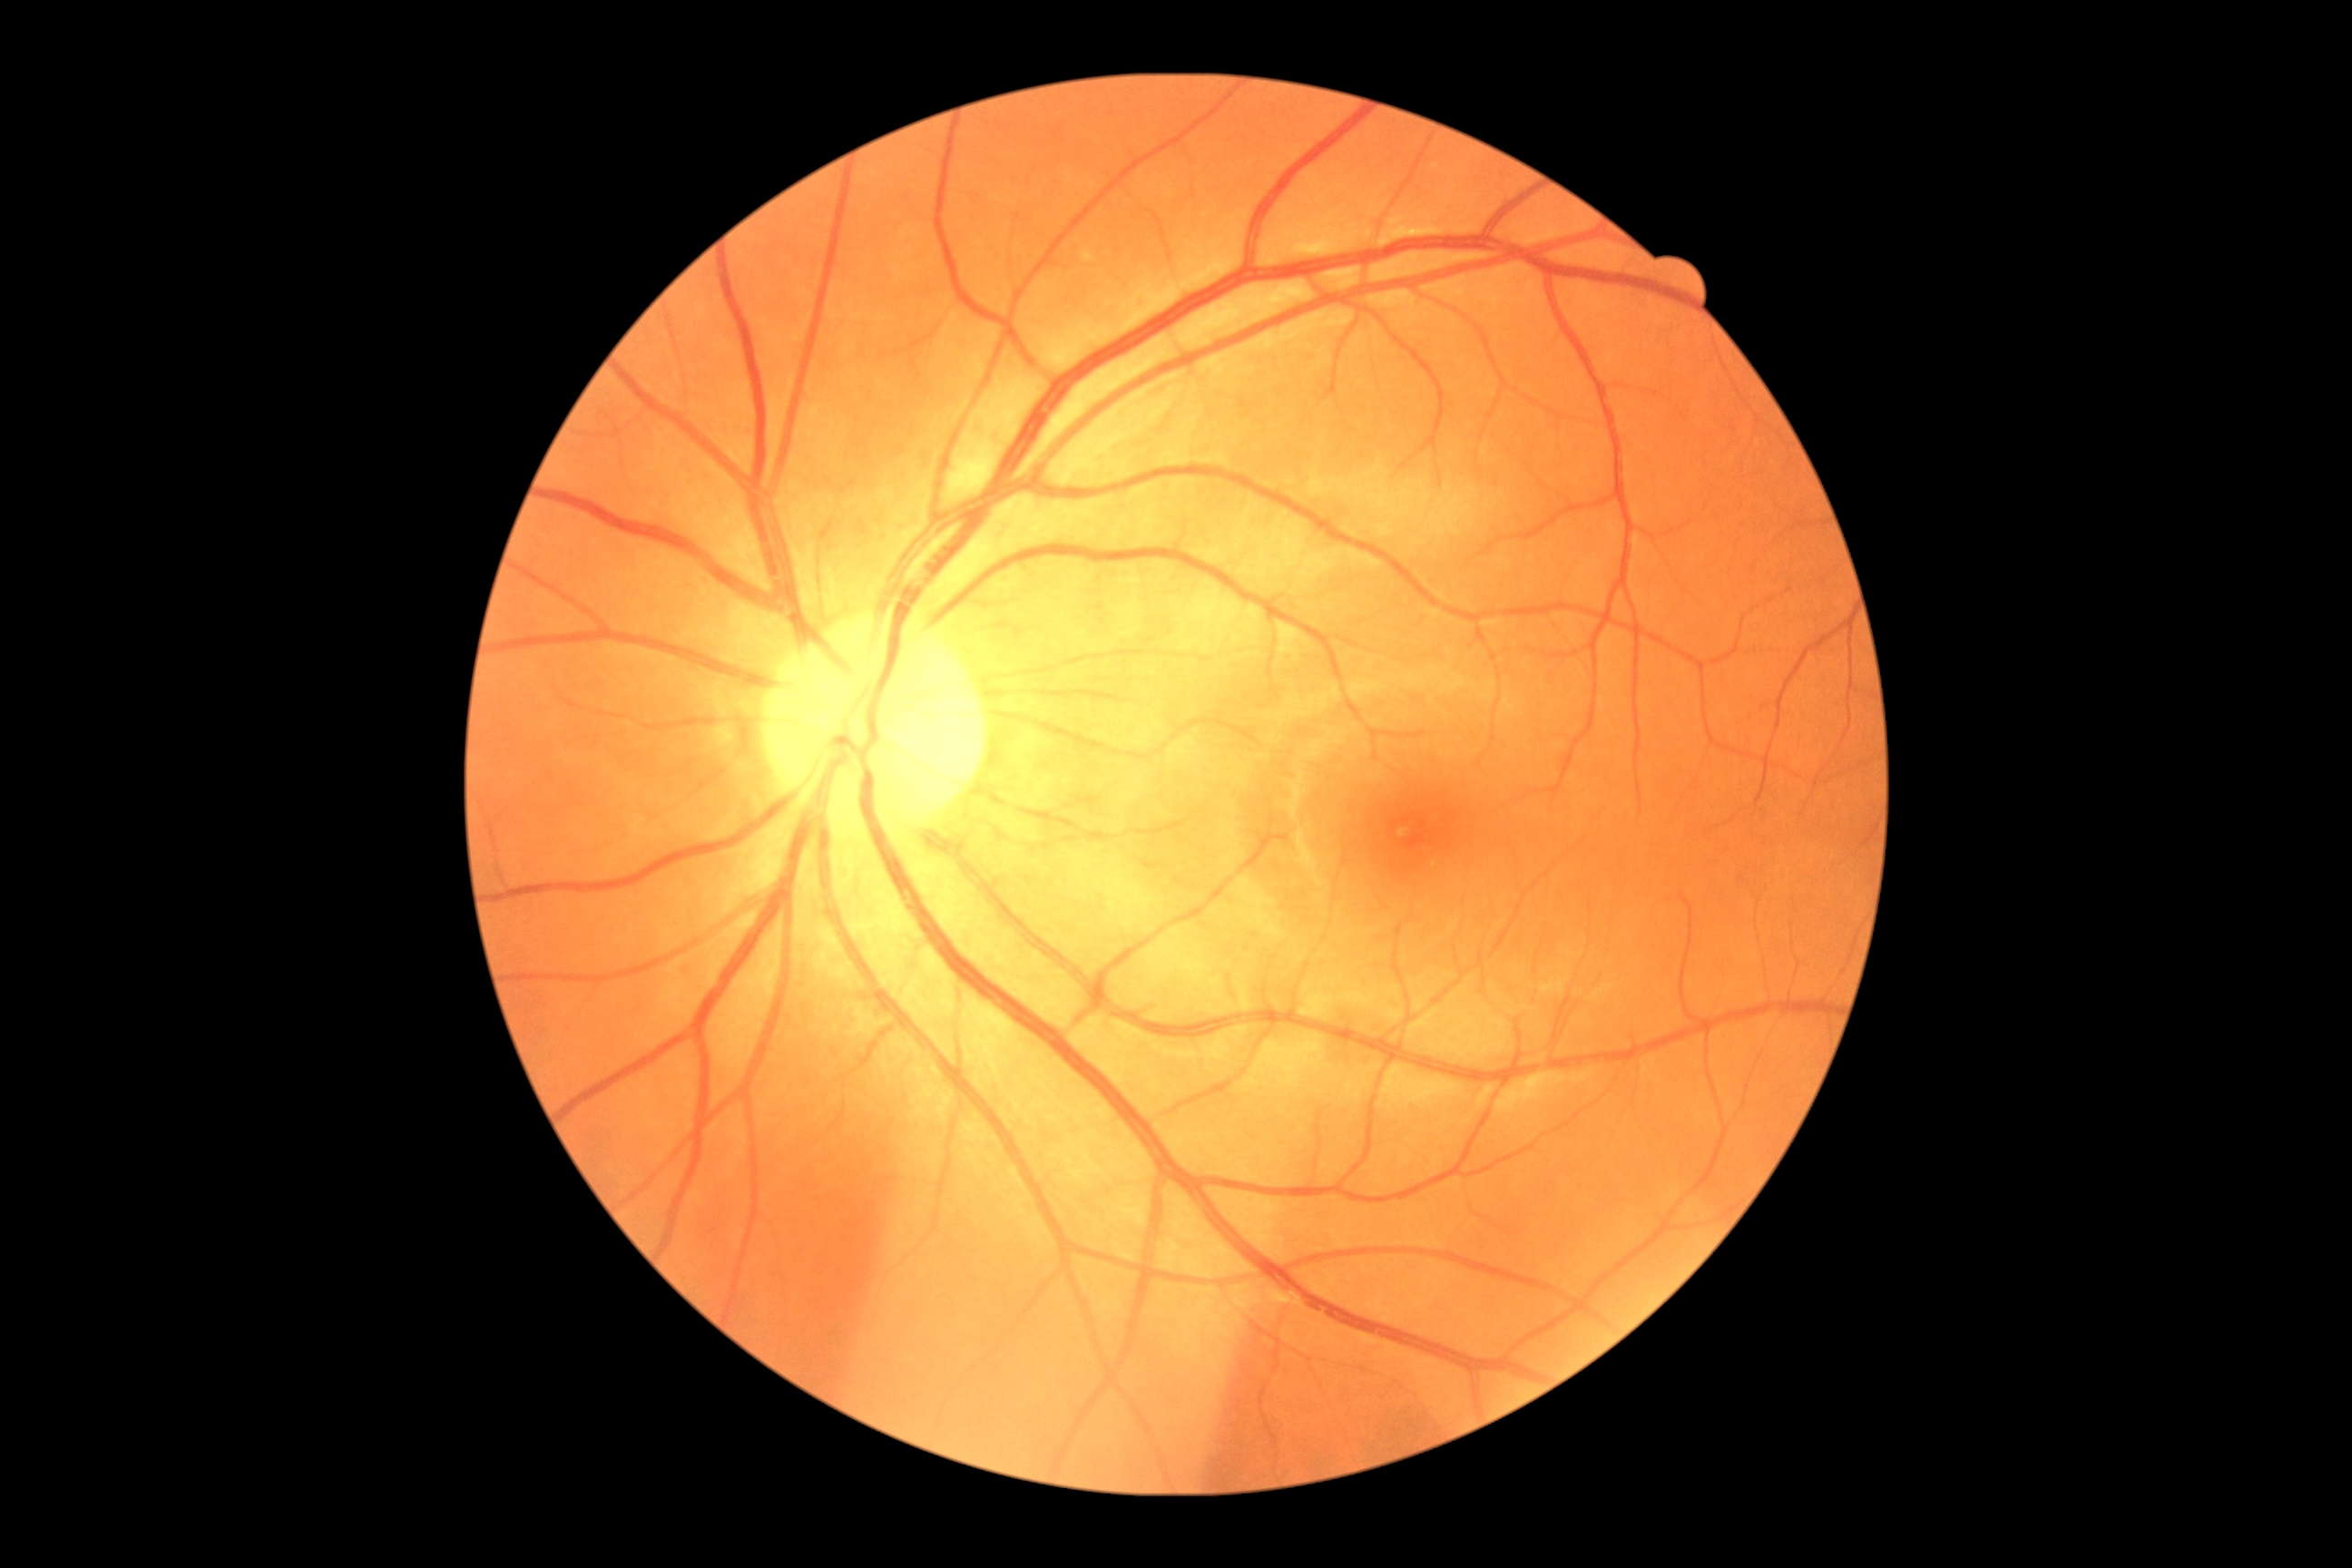 Diabetic retinopathy is 0/4.